45° FOV — 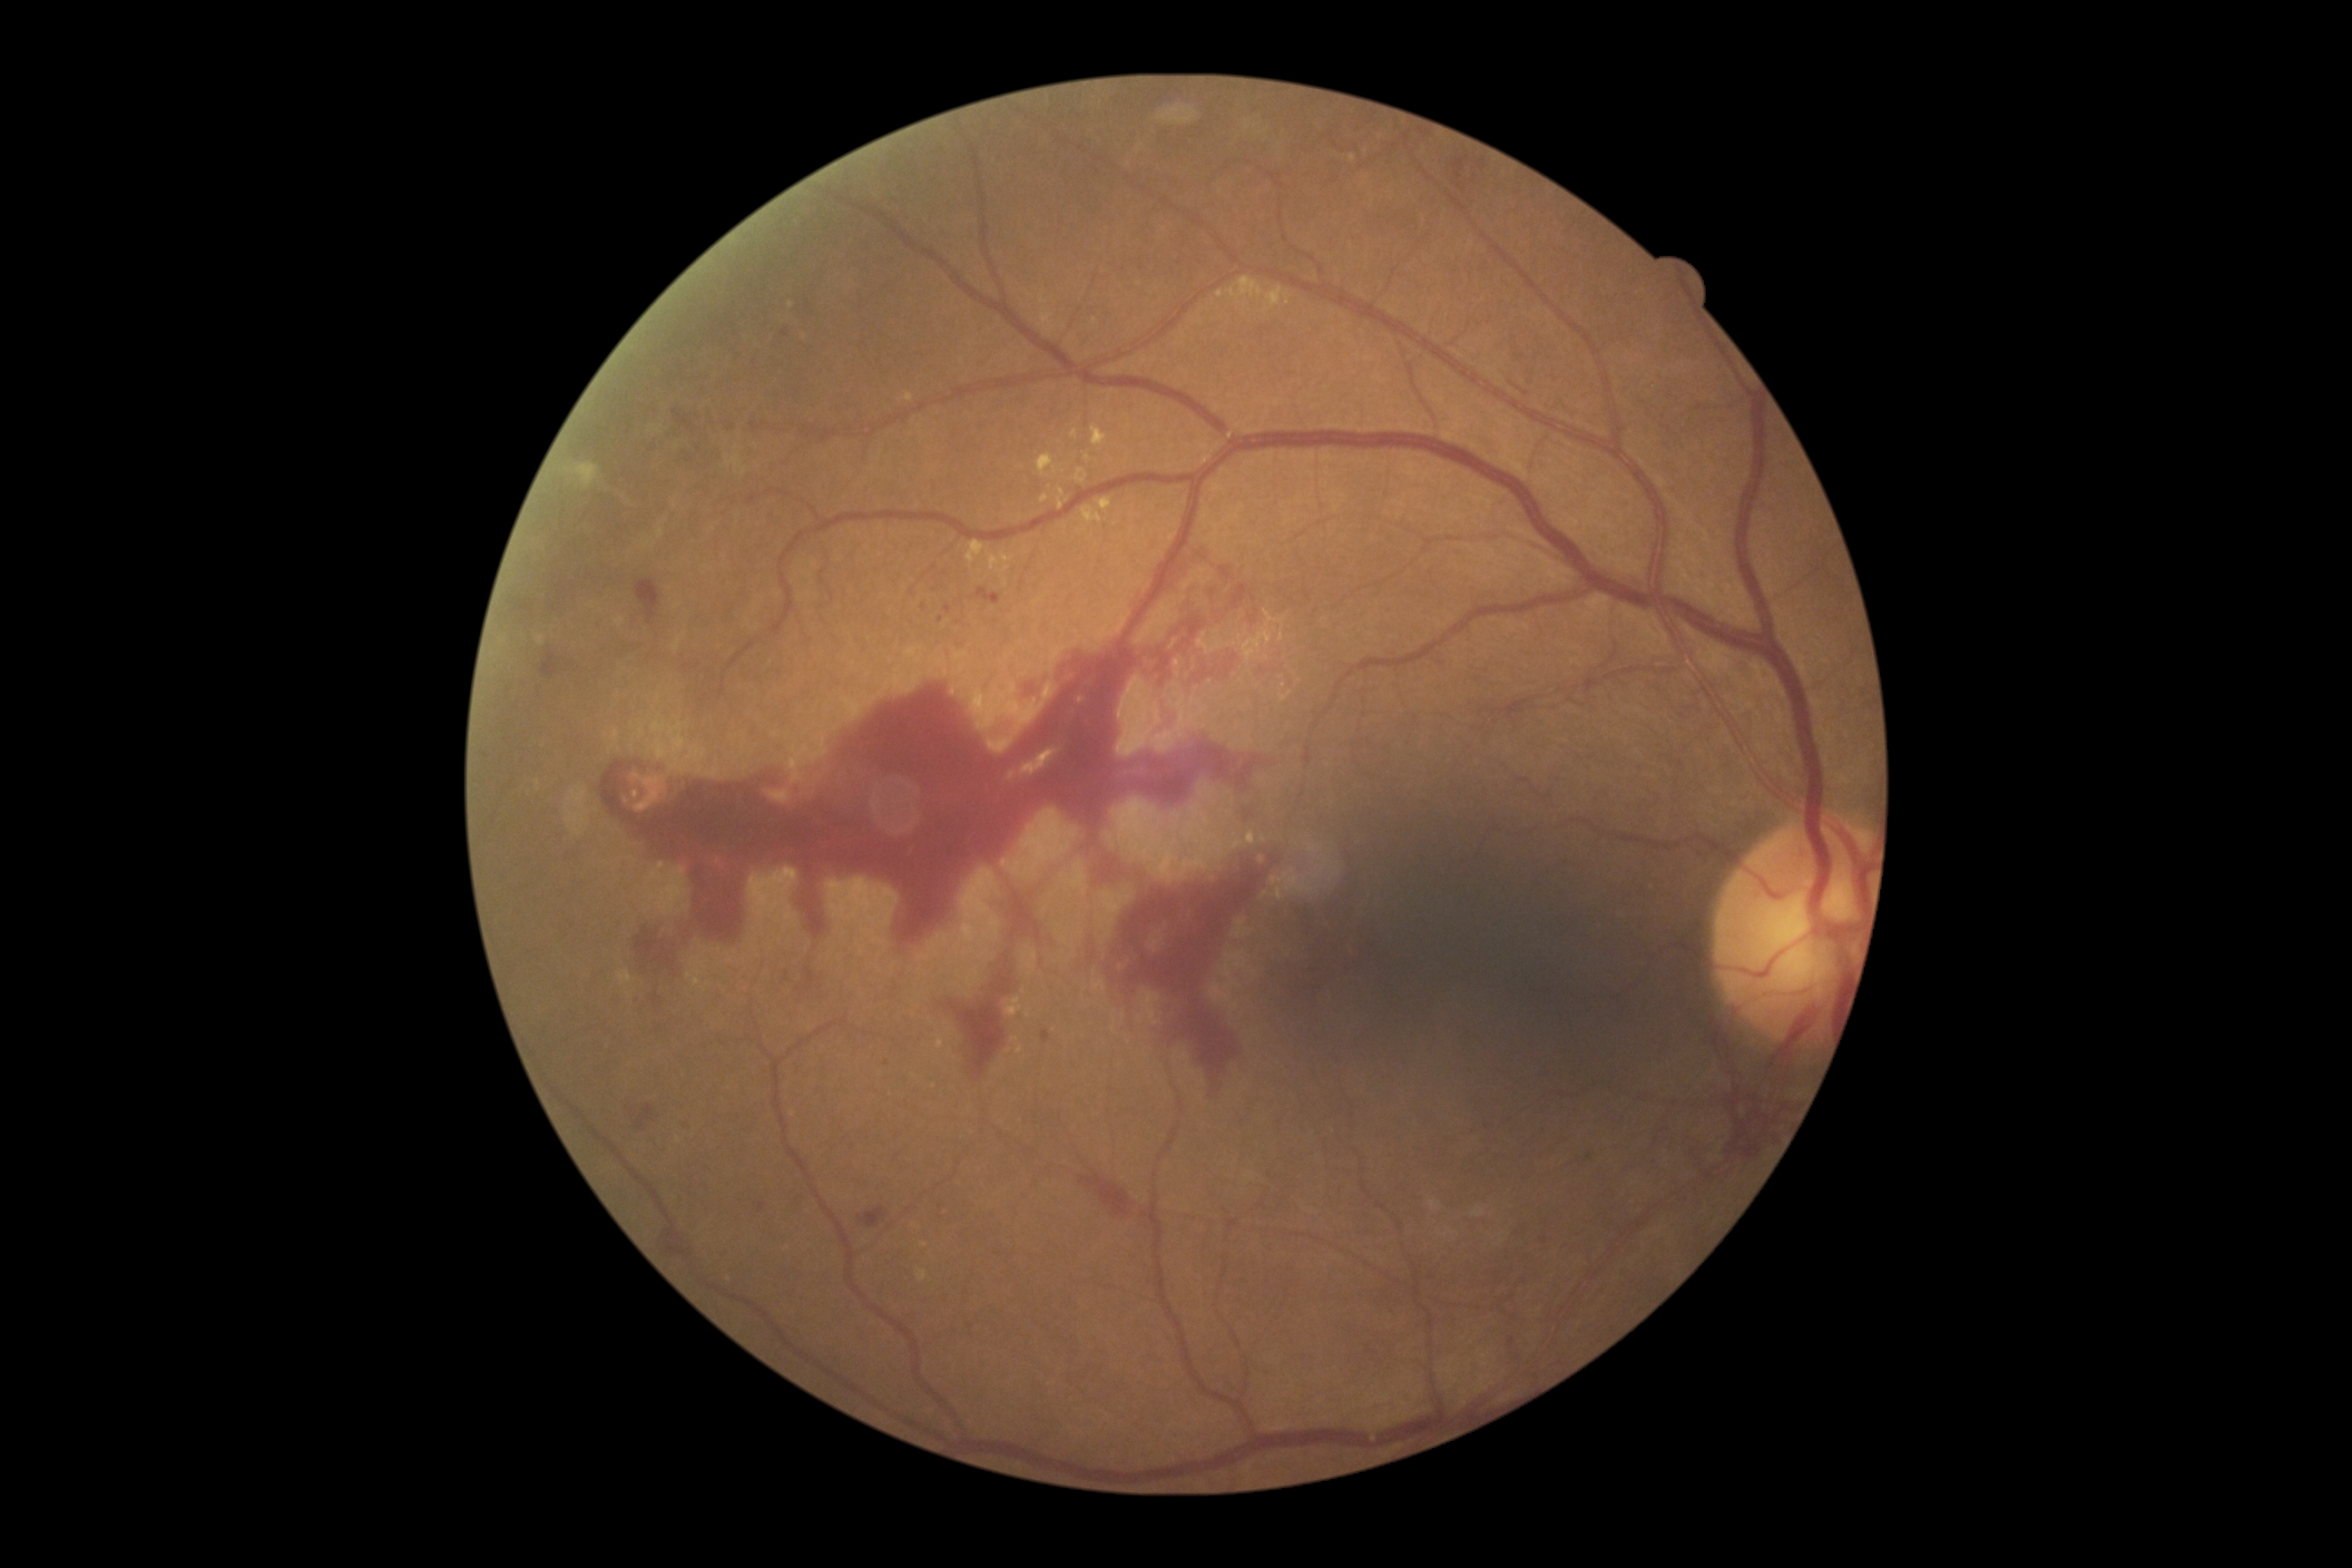 DR: grade 4 (PDR).